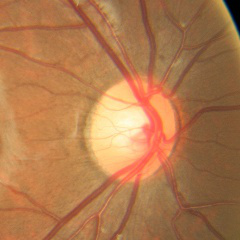 Diagnosis: no glaucomatous findings.